Modified Davis classification:
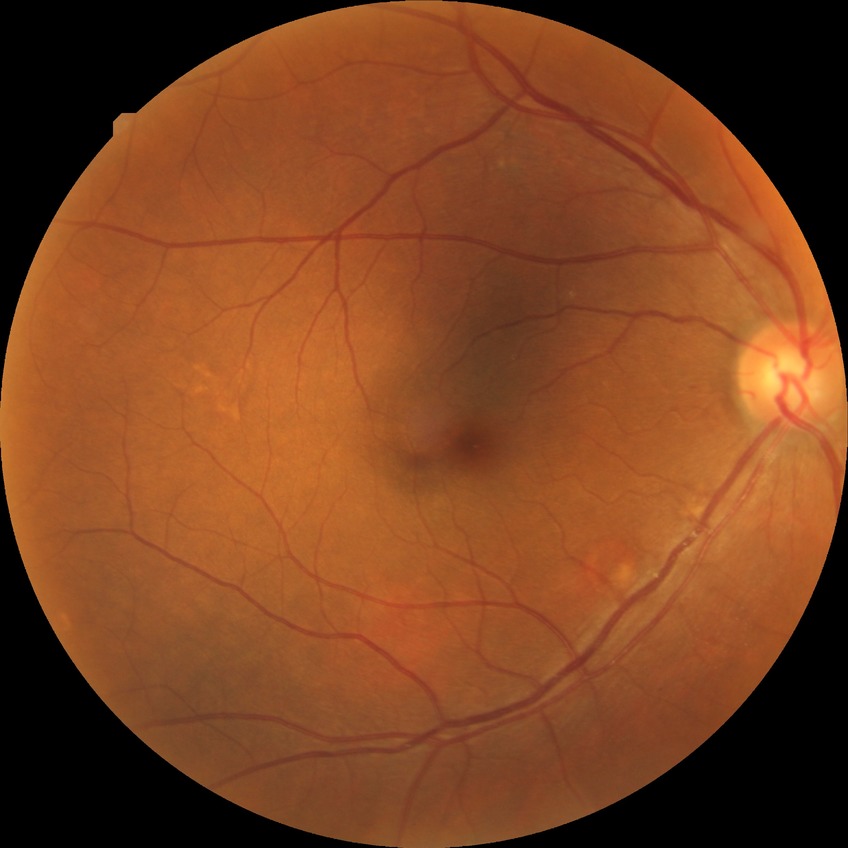

DR grade is SDR.
The retinopathy is classified as non-proliferative diabetic retinopathy.